848x848; color fundus image; nonmydriatic; FOV: 45 degrees — 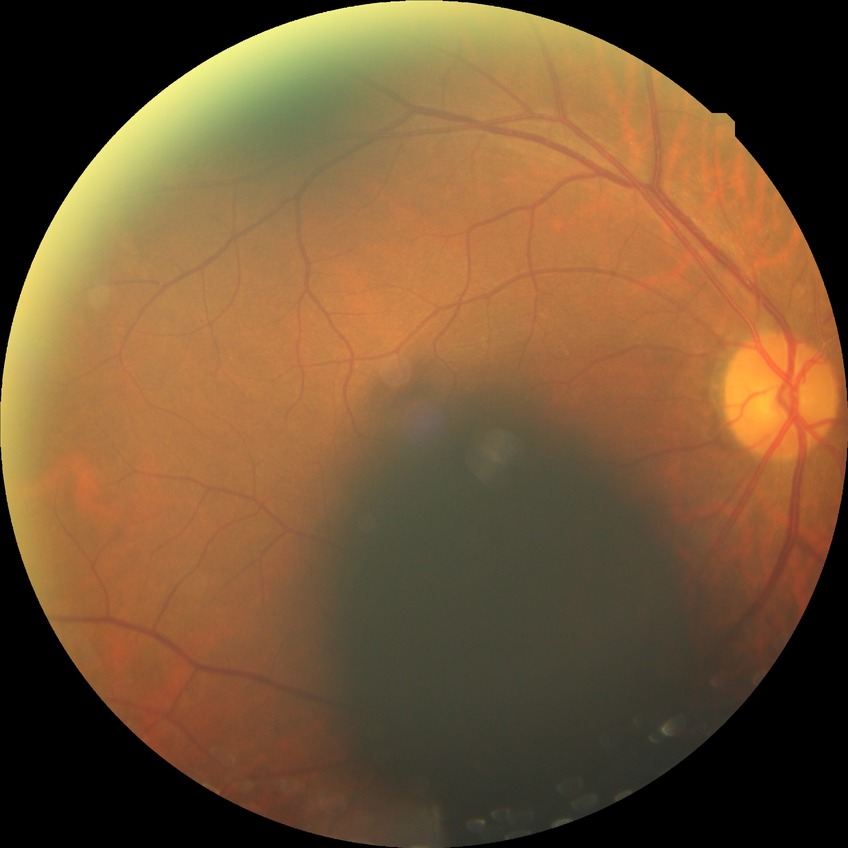

Annotations:
• diabetic retinopathy (DR) — no diabetic retinopathy (NDR)